45-degree field of view, 848x848px, graded on the modified Davis scale, fundus photo
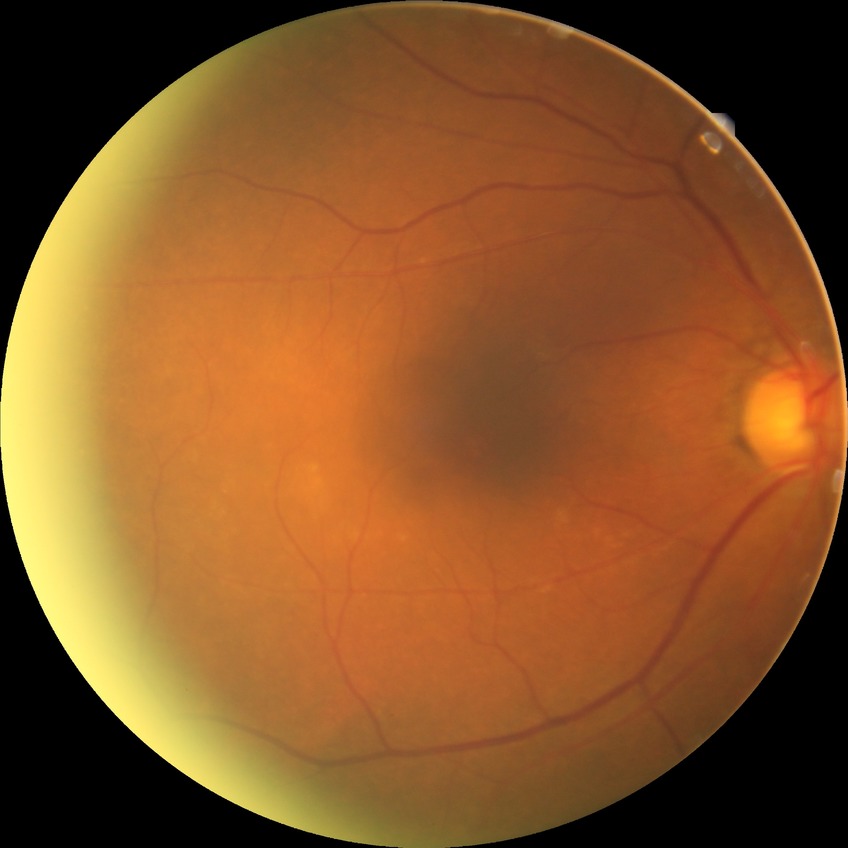

diabetic retinopathy (DR): NDR (no diabetic retinopathy).